Wide-field fundus photograph from neonatal ROP screening · camera: Clarity RetCam 3 (130° FOV): 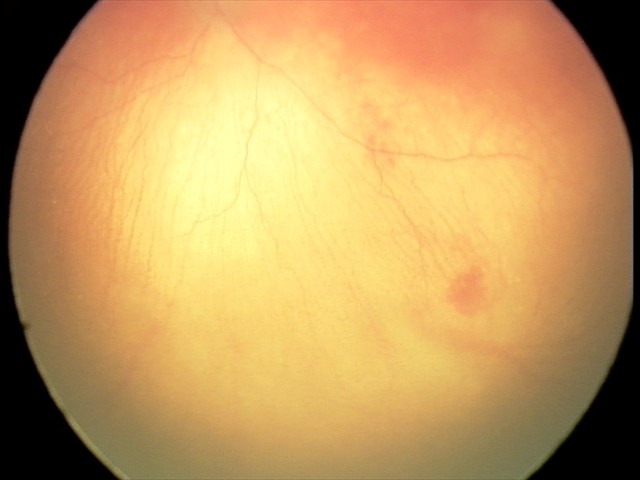

Plus form: present — abnormal dilation and tortuosity of the posterior pole retinal vessels | assessment: aggressive ROP (A-ROP).